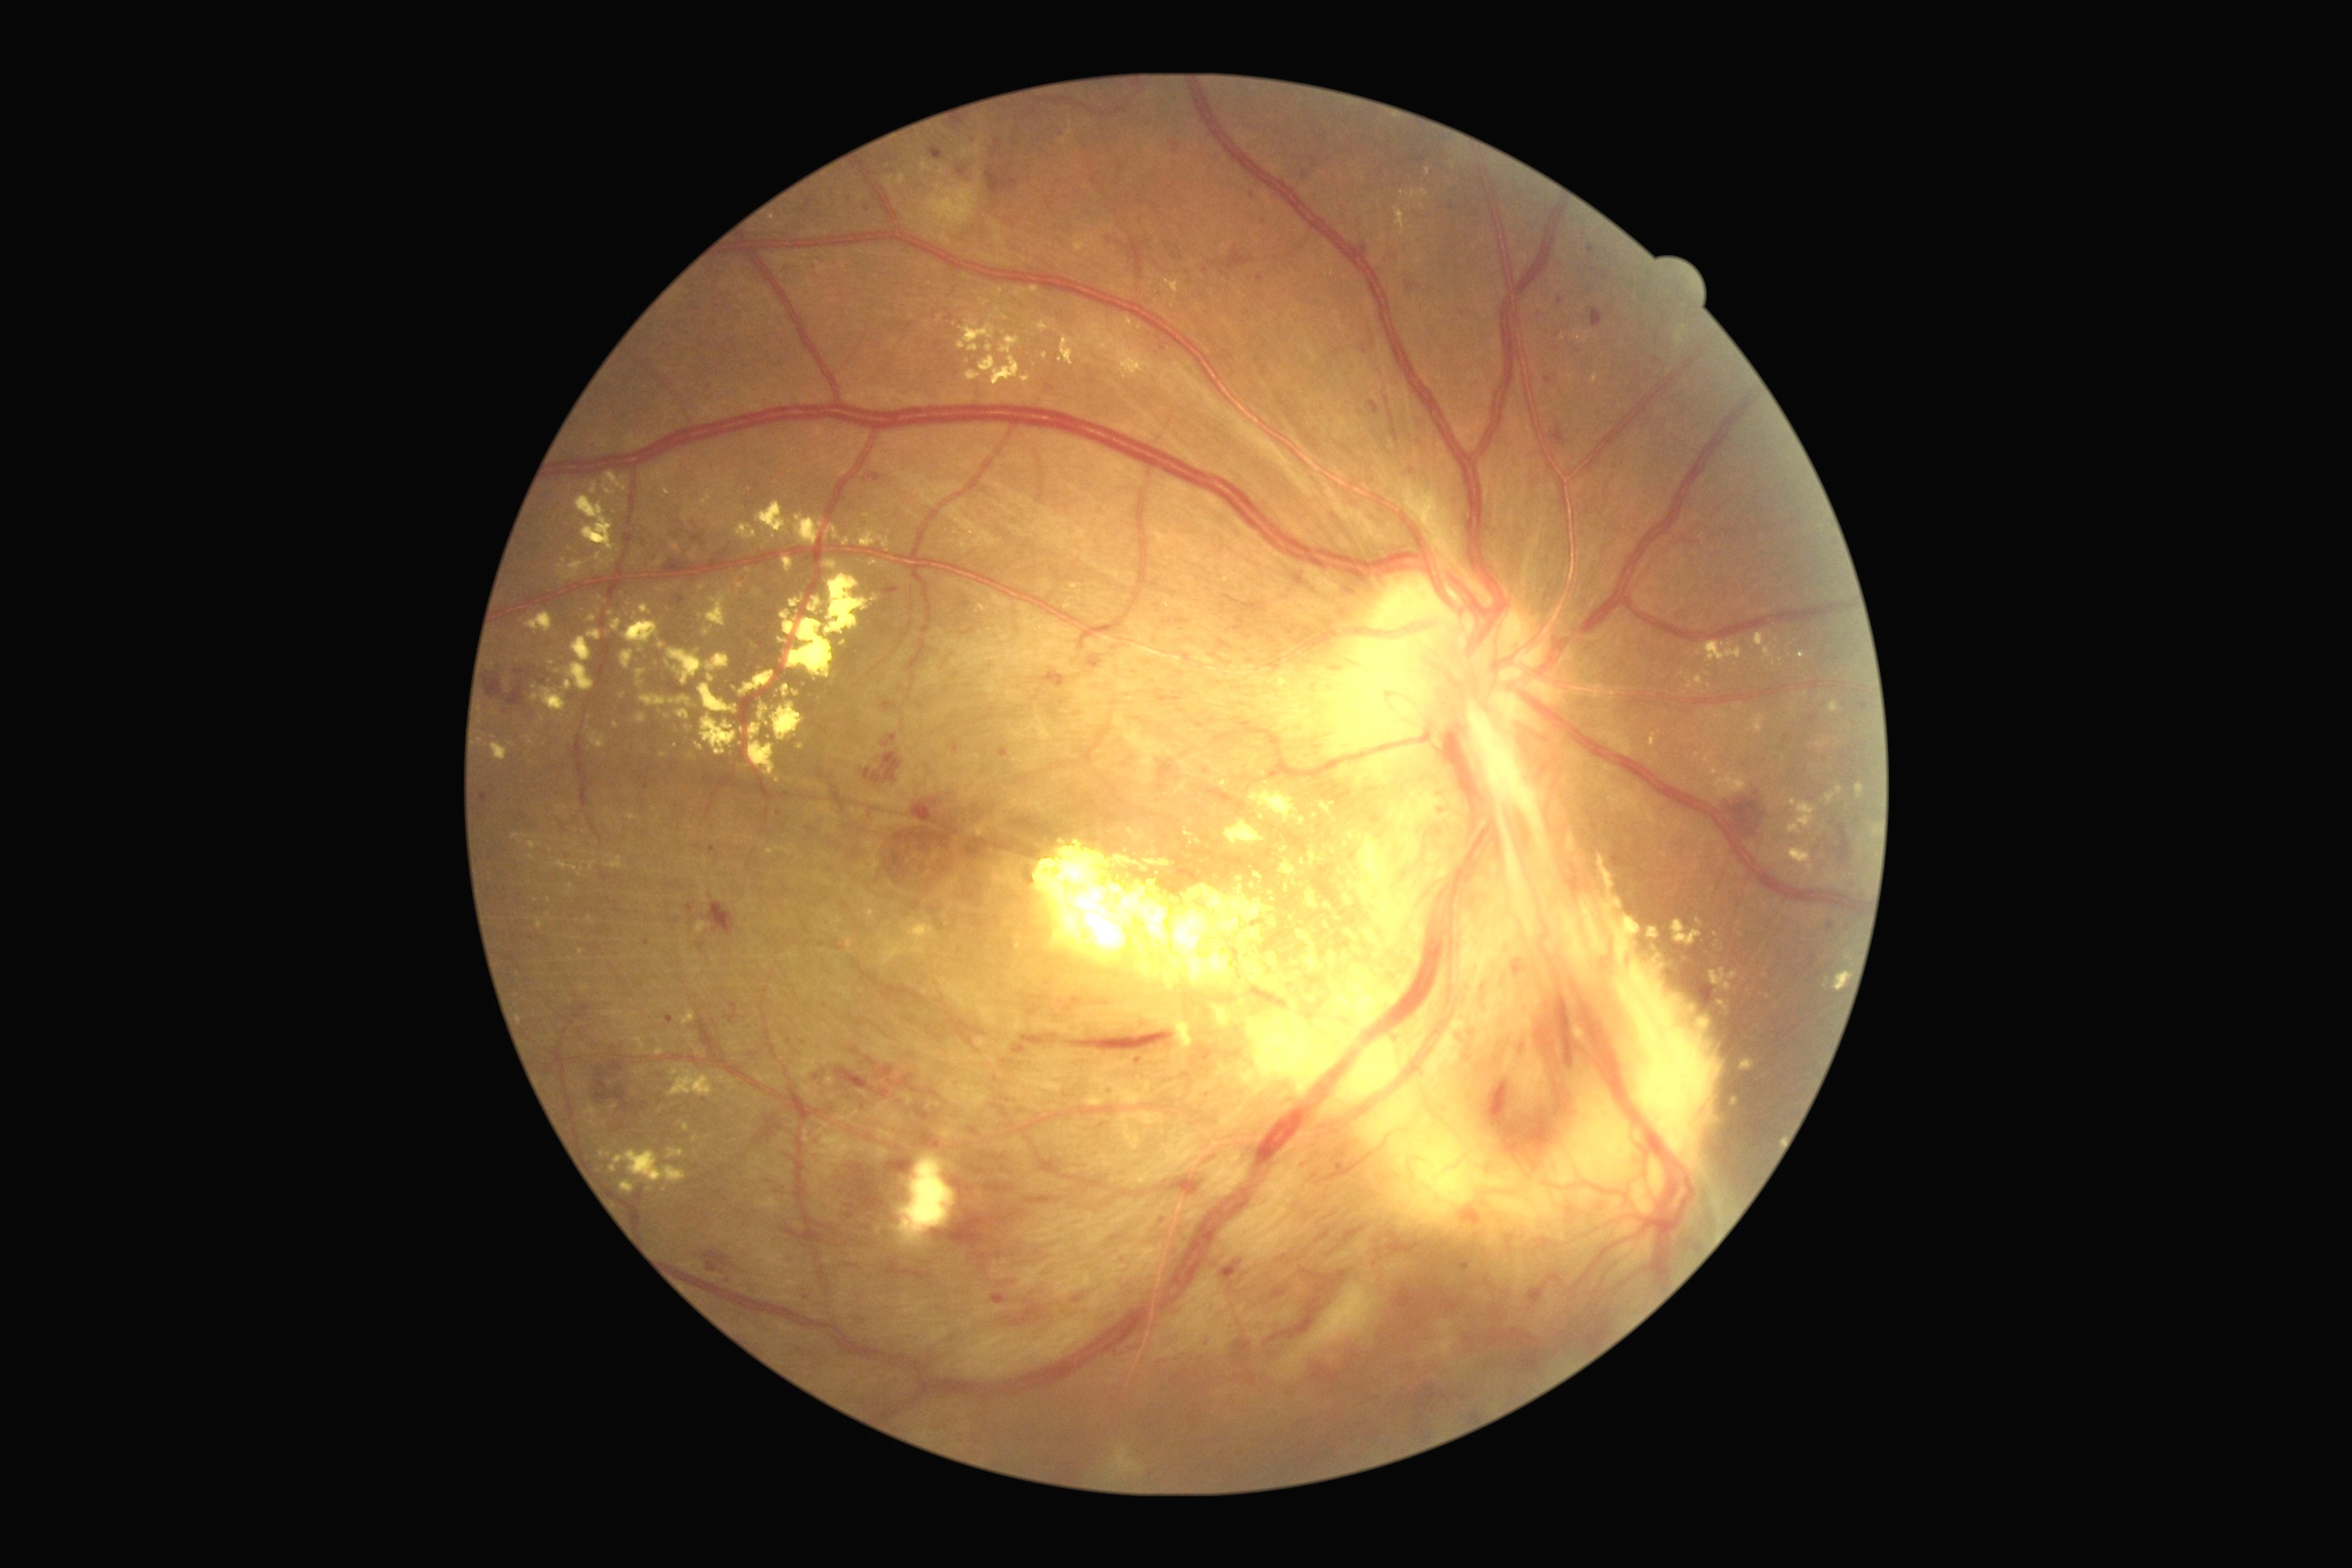
Diabetic retinopathy (DR) is grade 4 (PDR). Hard exudates (EXs) (partial list) at 774 685 781 696 | 1689 676 1703 689 | 1250 783 1306 827 | 1248 963 1277 990 | 622 651 634 669 | 698 585 707 591 | 1856 783 1865 799 | 1124 318 1133 333 | 1716 712 1725 720 | 627 814 640 821 | 779 611 796 636 | 1224 819 1266 847 | 1306 888 1320 910 | 703 496 709 504 | 1427 168 1431 177. Small EXs near [x=1295, y=885] | [x=804, y=684] | [x=571, y=551] | [x=551, y=663].